Captured with the Clarity RetCam 3 (130° field of view) · pediatric retinal photograph (wide-field) · 640 by 480 pixels
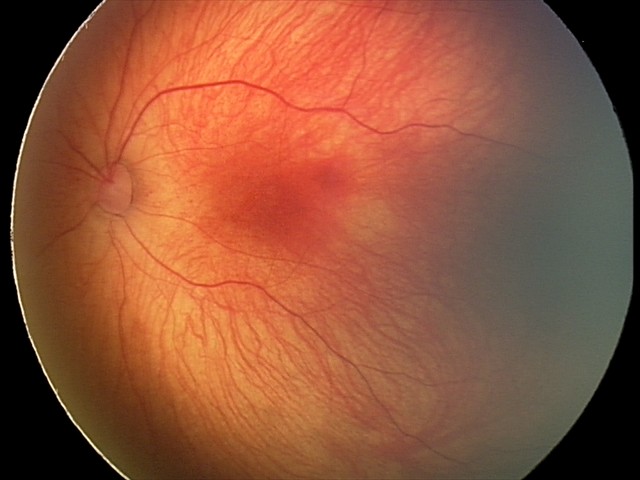 Series diagnosed as retinal hemorrhages.